Color fundus image; 45° FOV; 1536x1152px
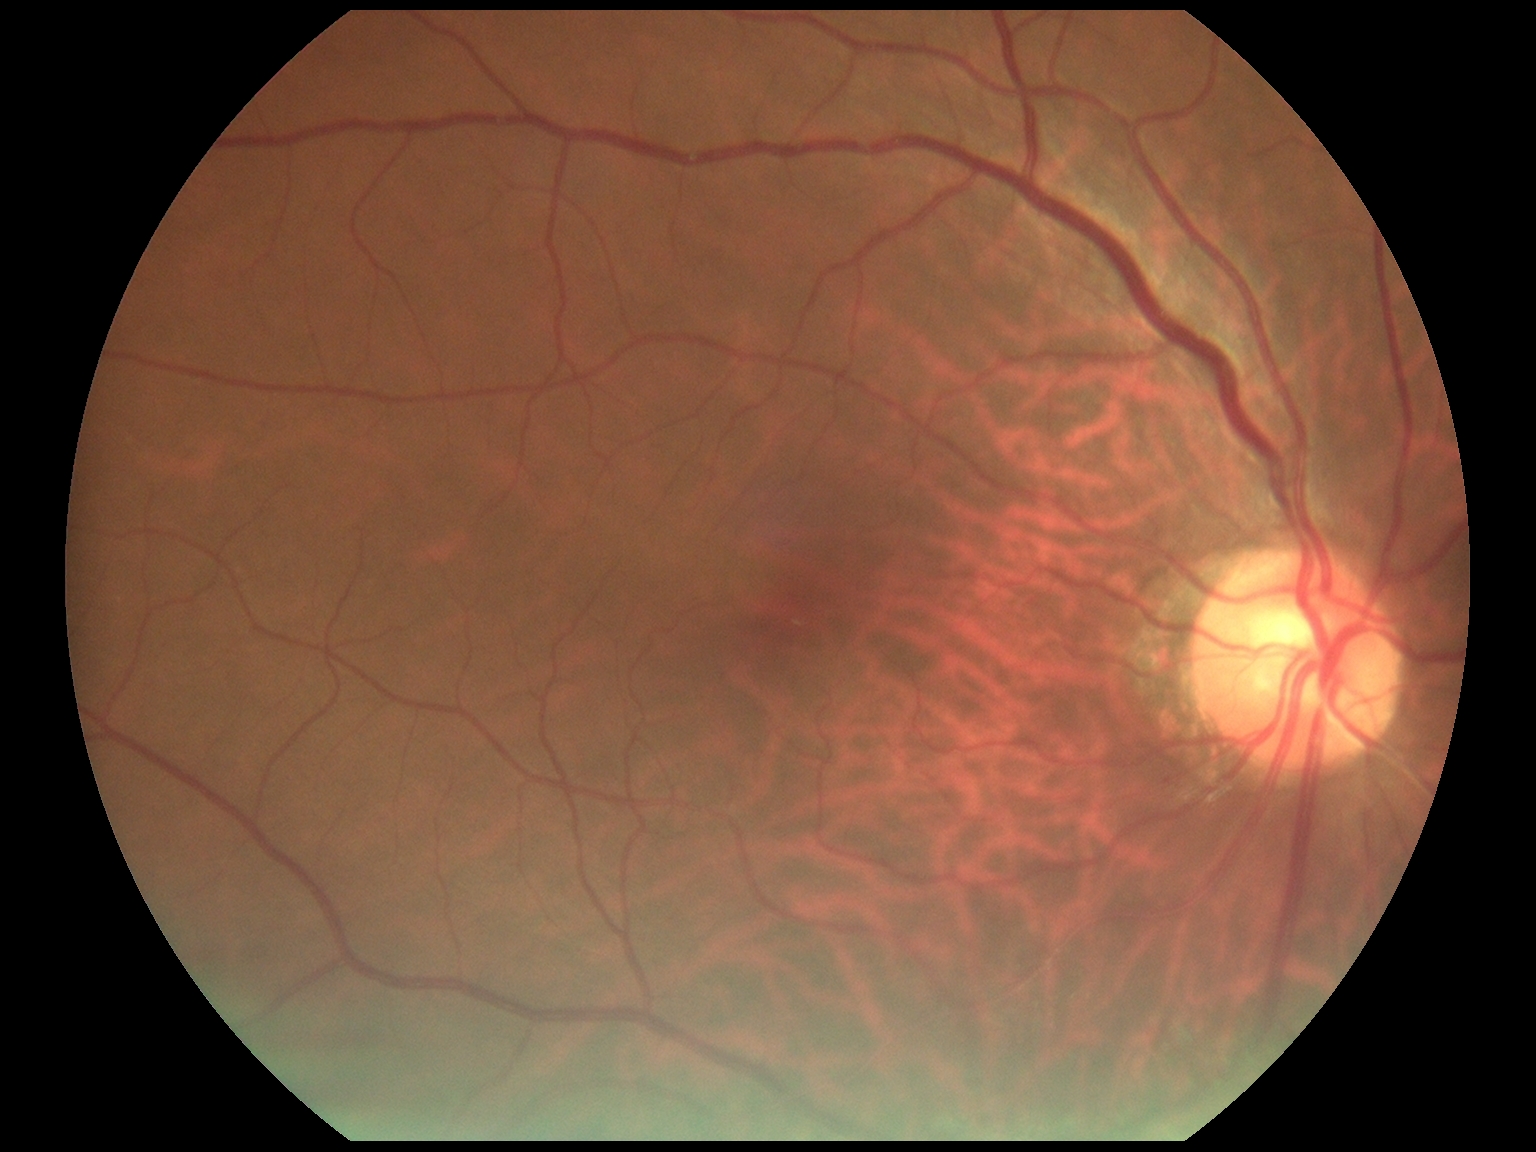
Diabetic retinopathy (DR): grade 0 — no visible signs of diabetic retinopathy. No diabetic retinal disease findings.